2361x1568px. Pupil-dilated.
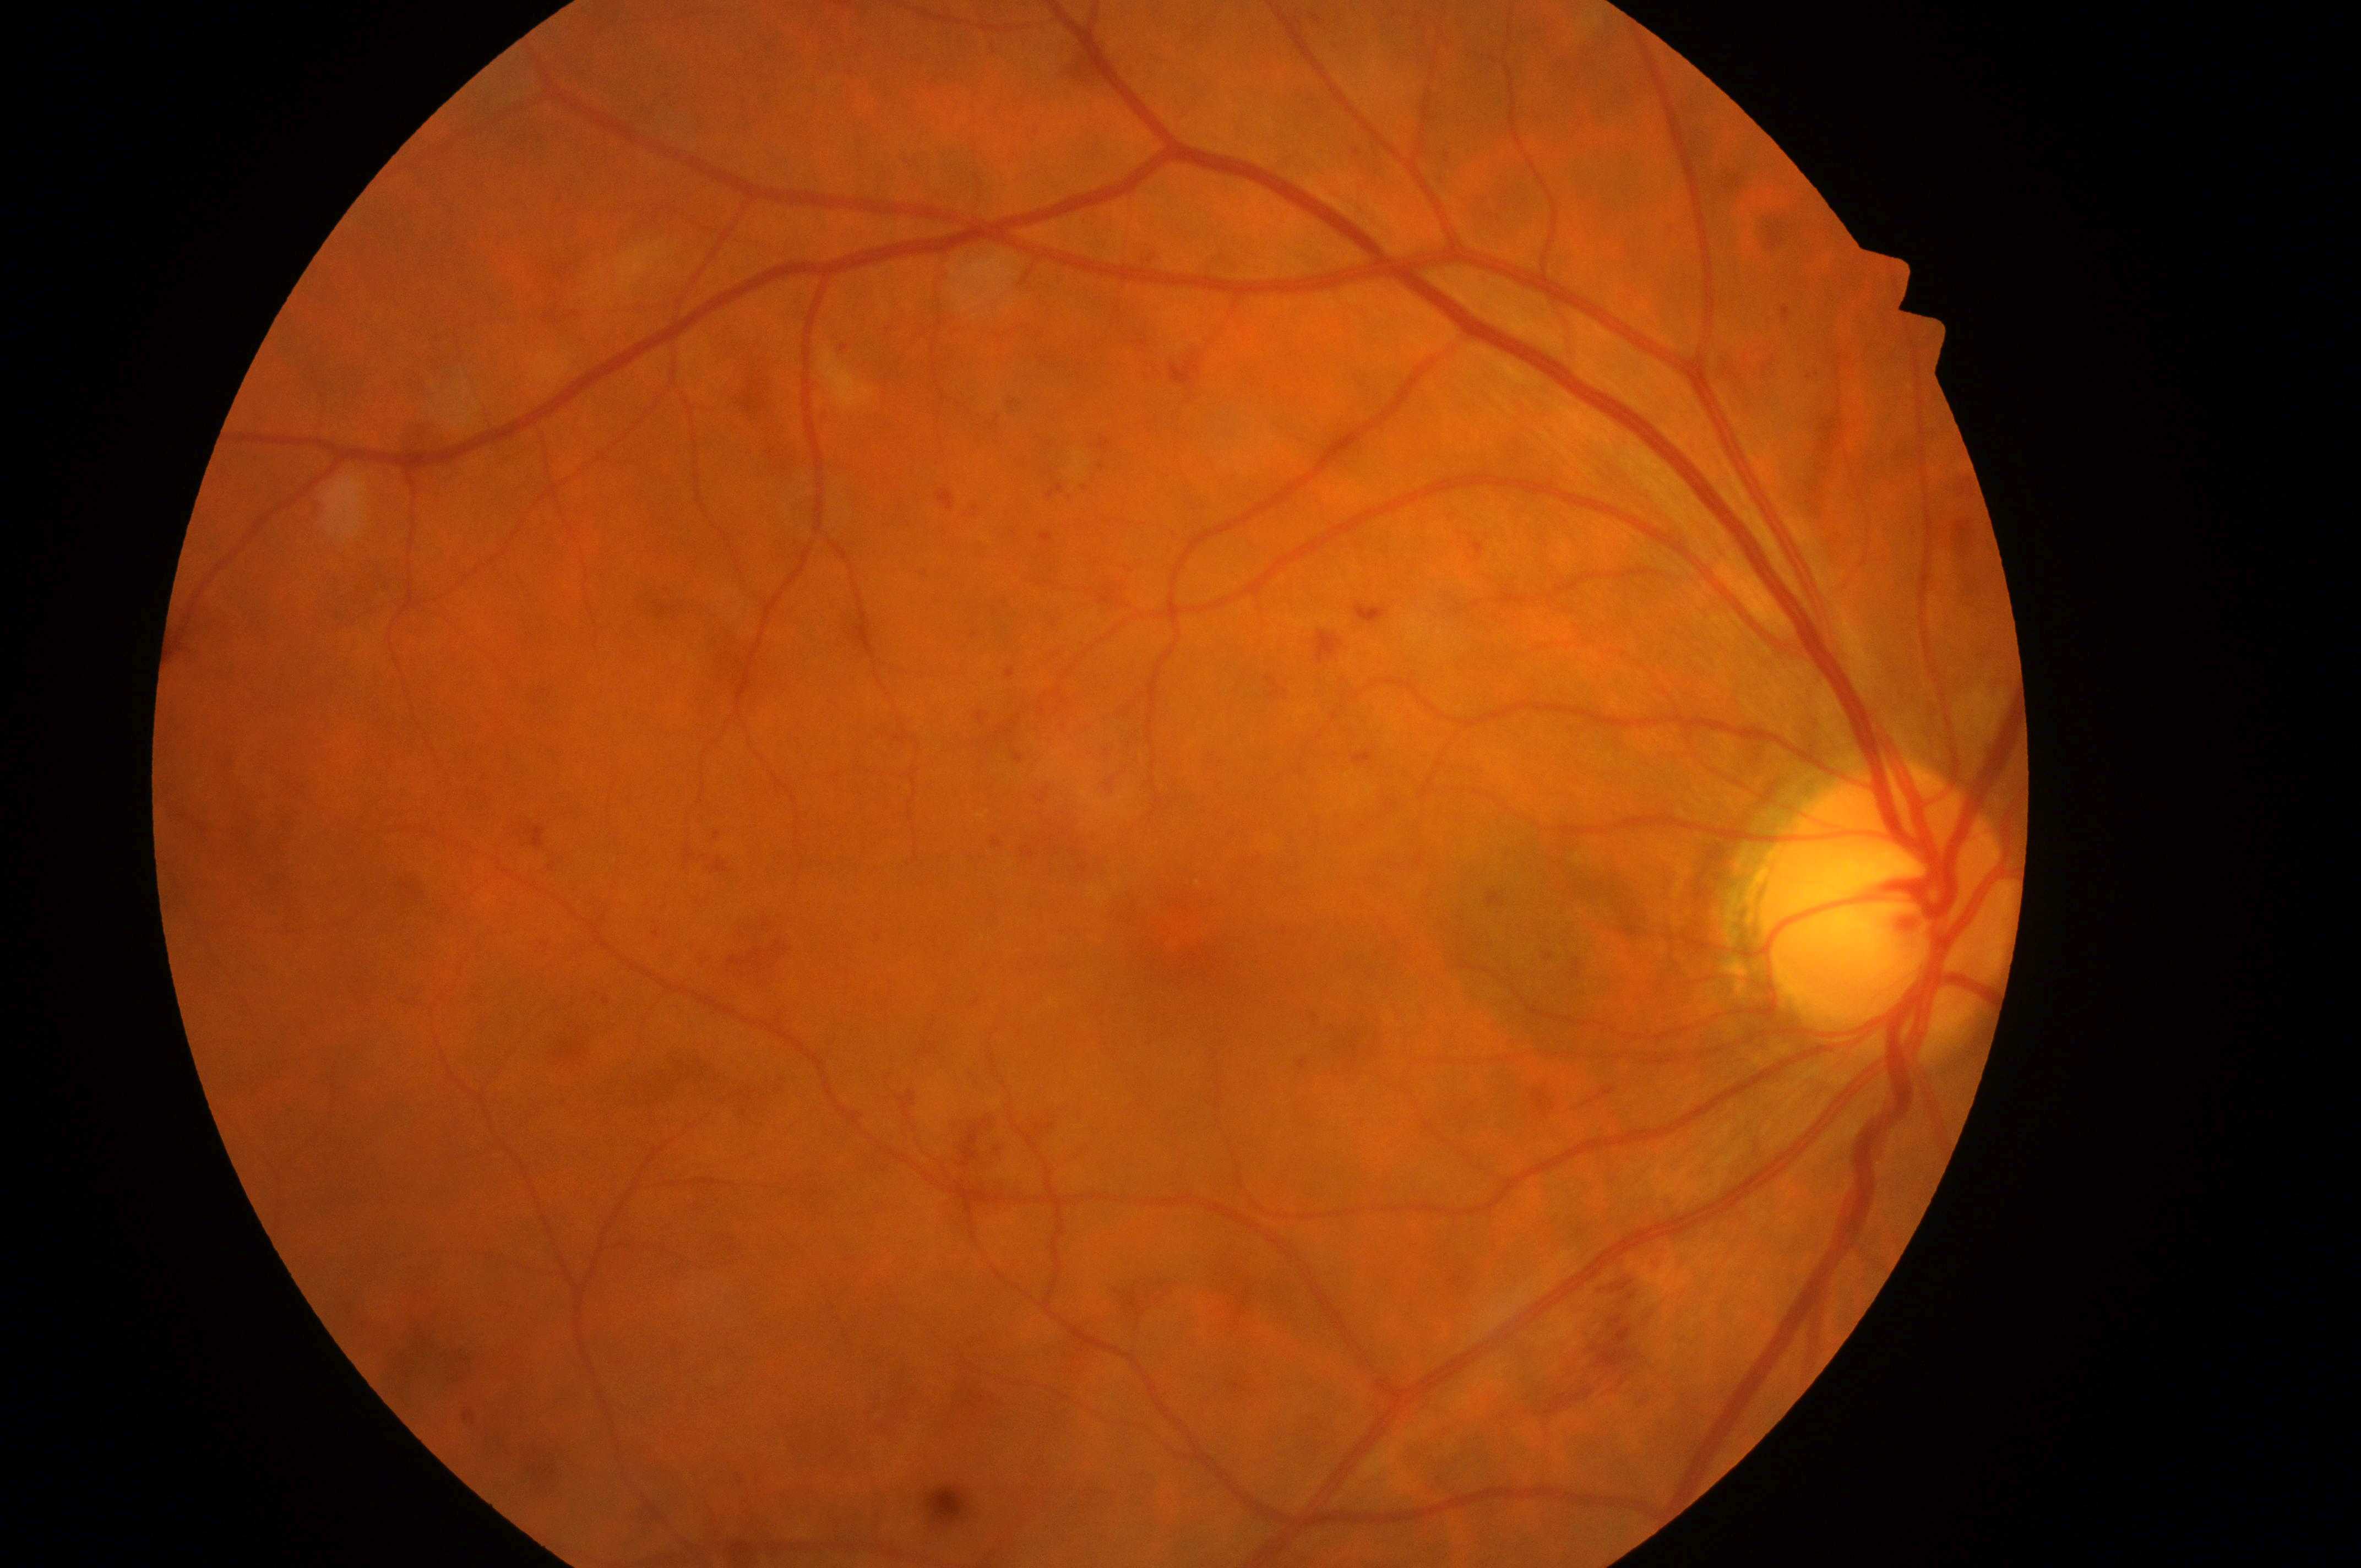 Optic nerve head located at (x: 1881, y: 919). Eye: oculus dexter. DR grade is 3. DME risk is 2. Foveal center located at (x: 1182, y: 932).